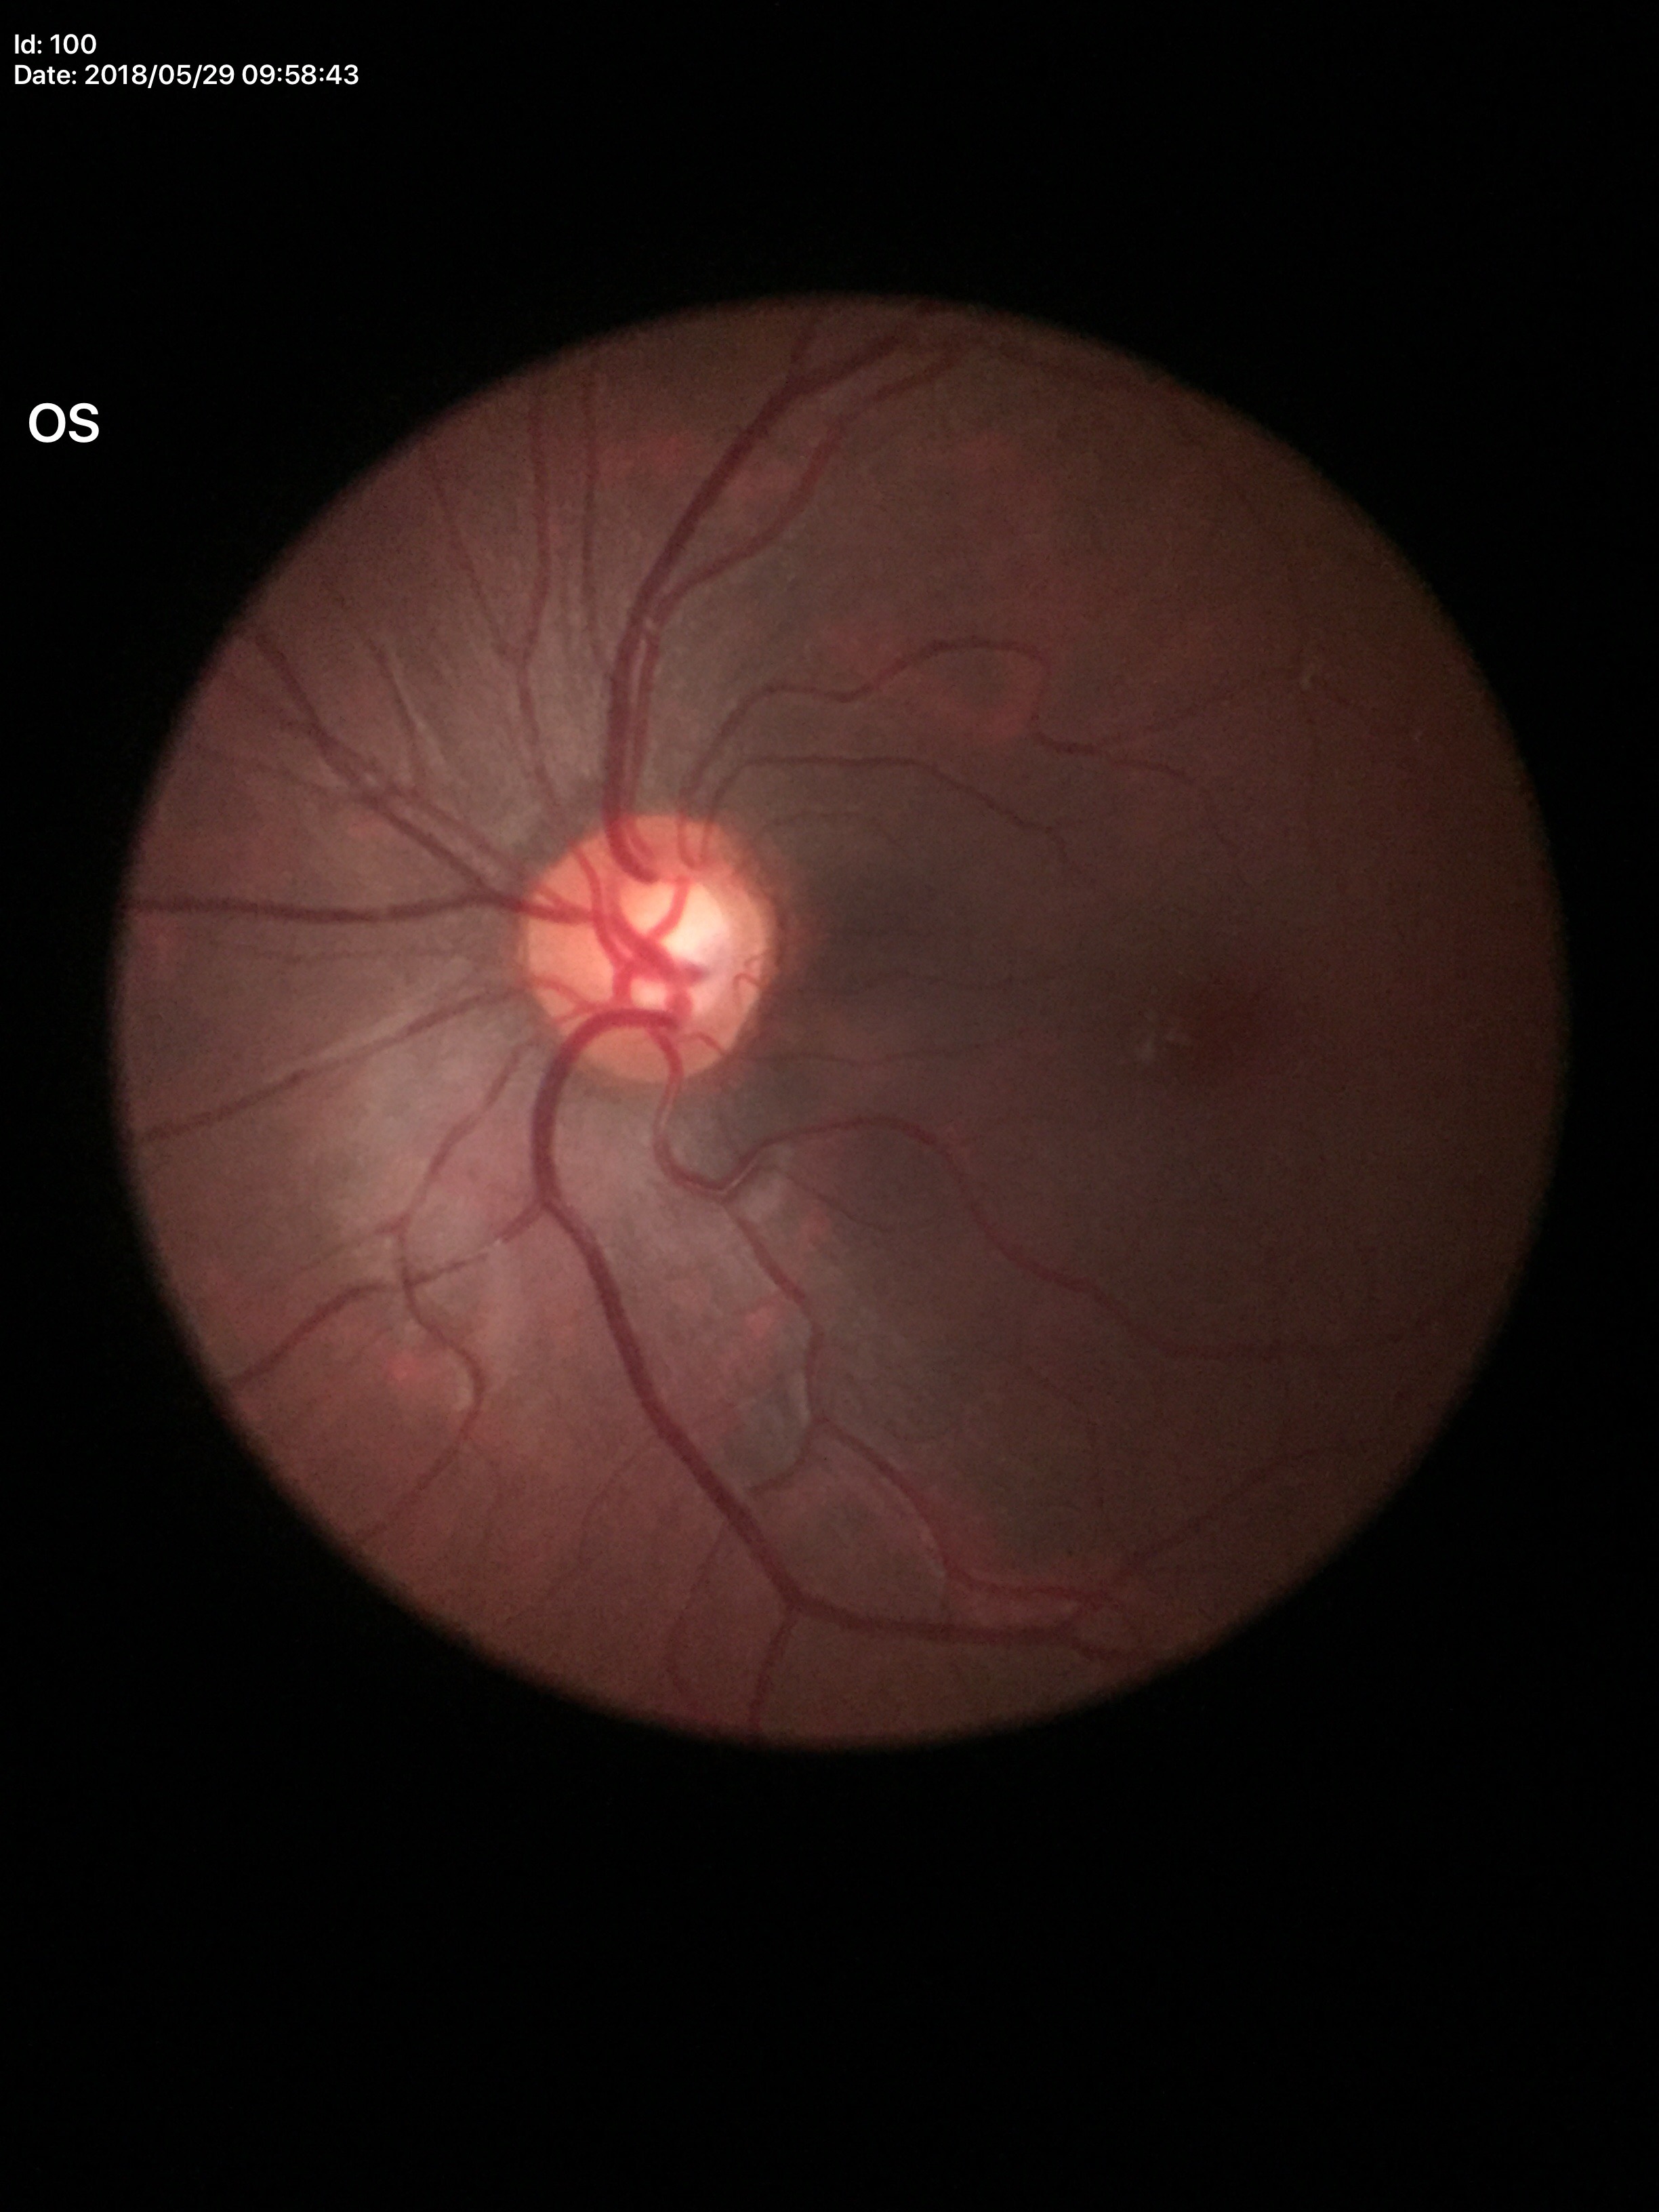 Glaucoma screening impression=suspicious | VCDR=0.62